Color fundus photograph — 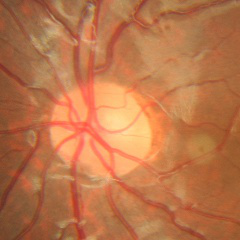

Glaucoma assessment: no glaucomatous findings.